45-degree field of view:
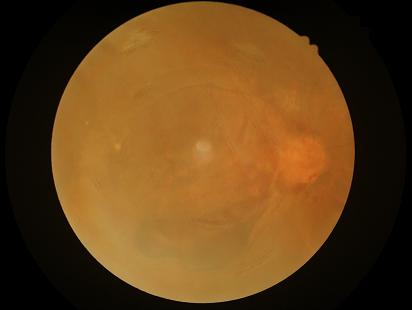
Quality grading: contrast: poor dynamic range | focus: reduced sharpness with visible blur | overall: poor and difficult to use diagnostically.